Wide-field contact fundus photograph of an infant:
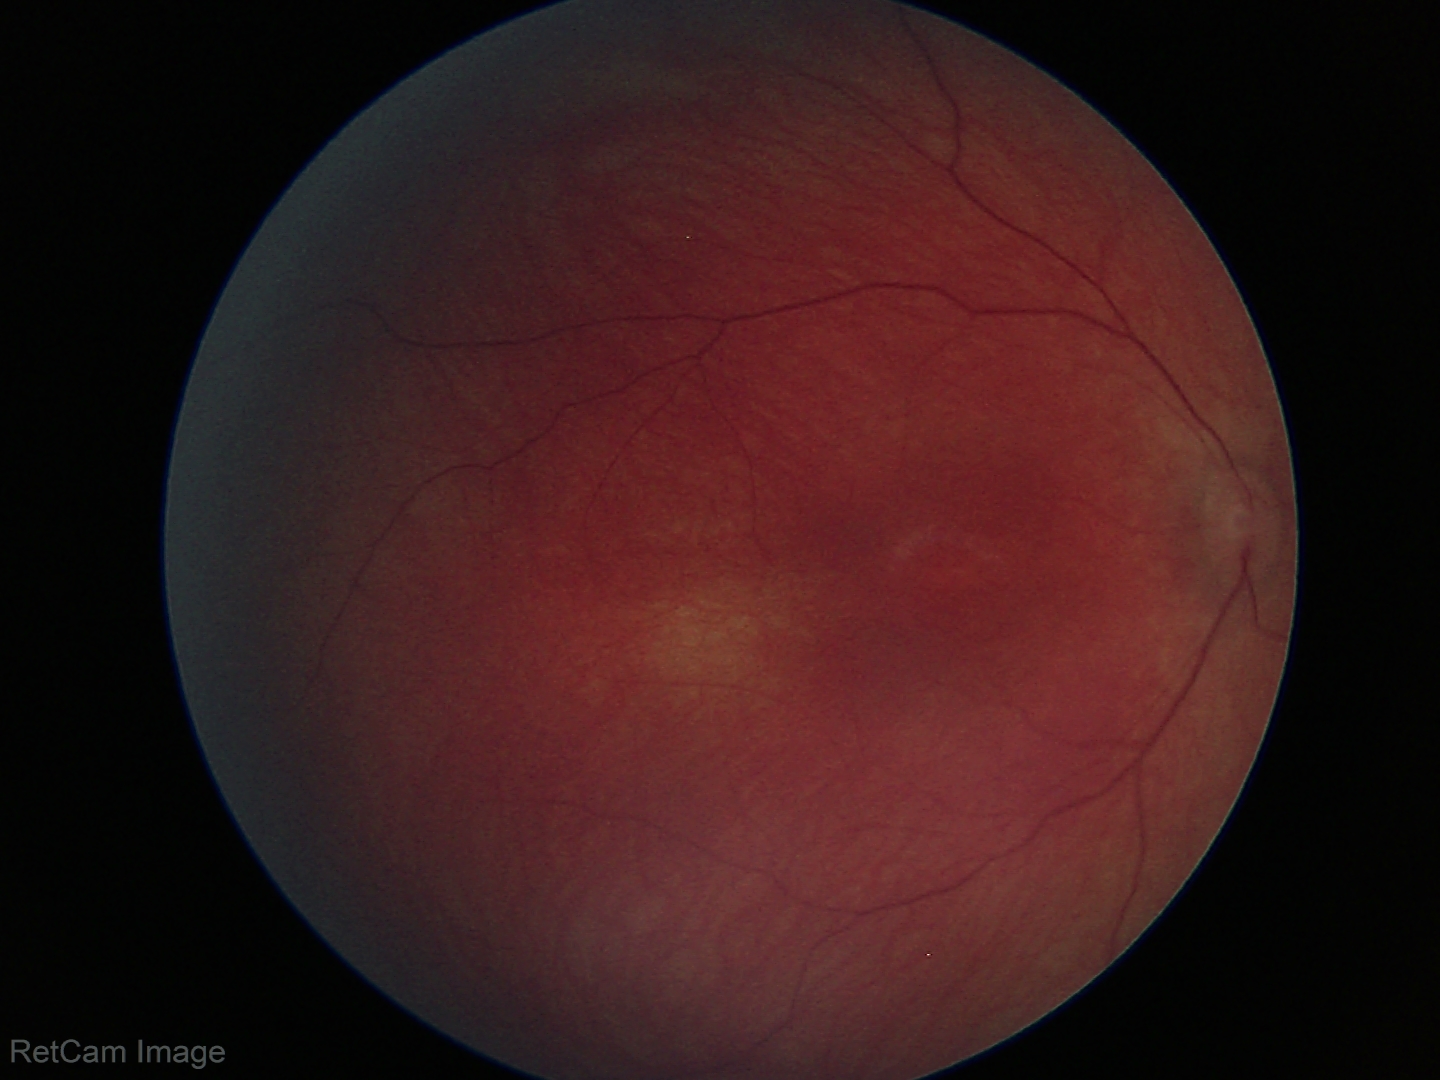
No retinal pathology identified on screening.